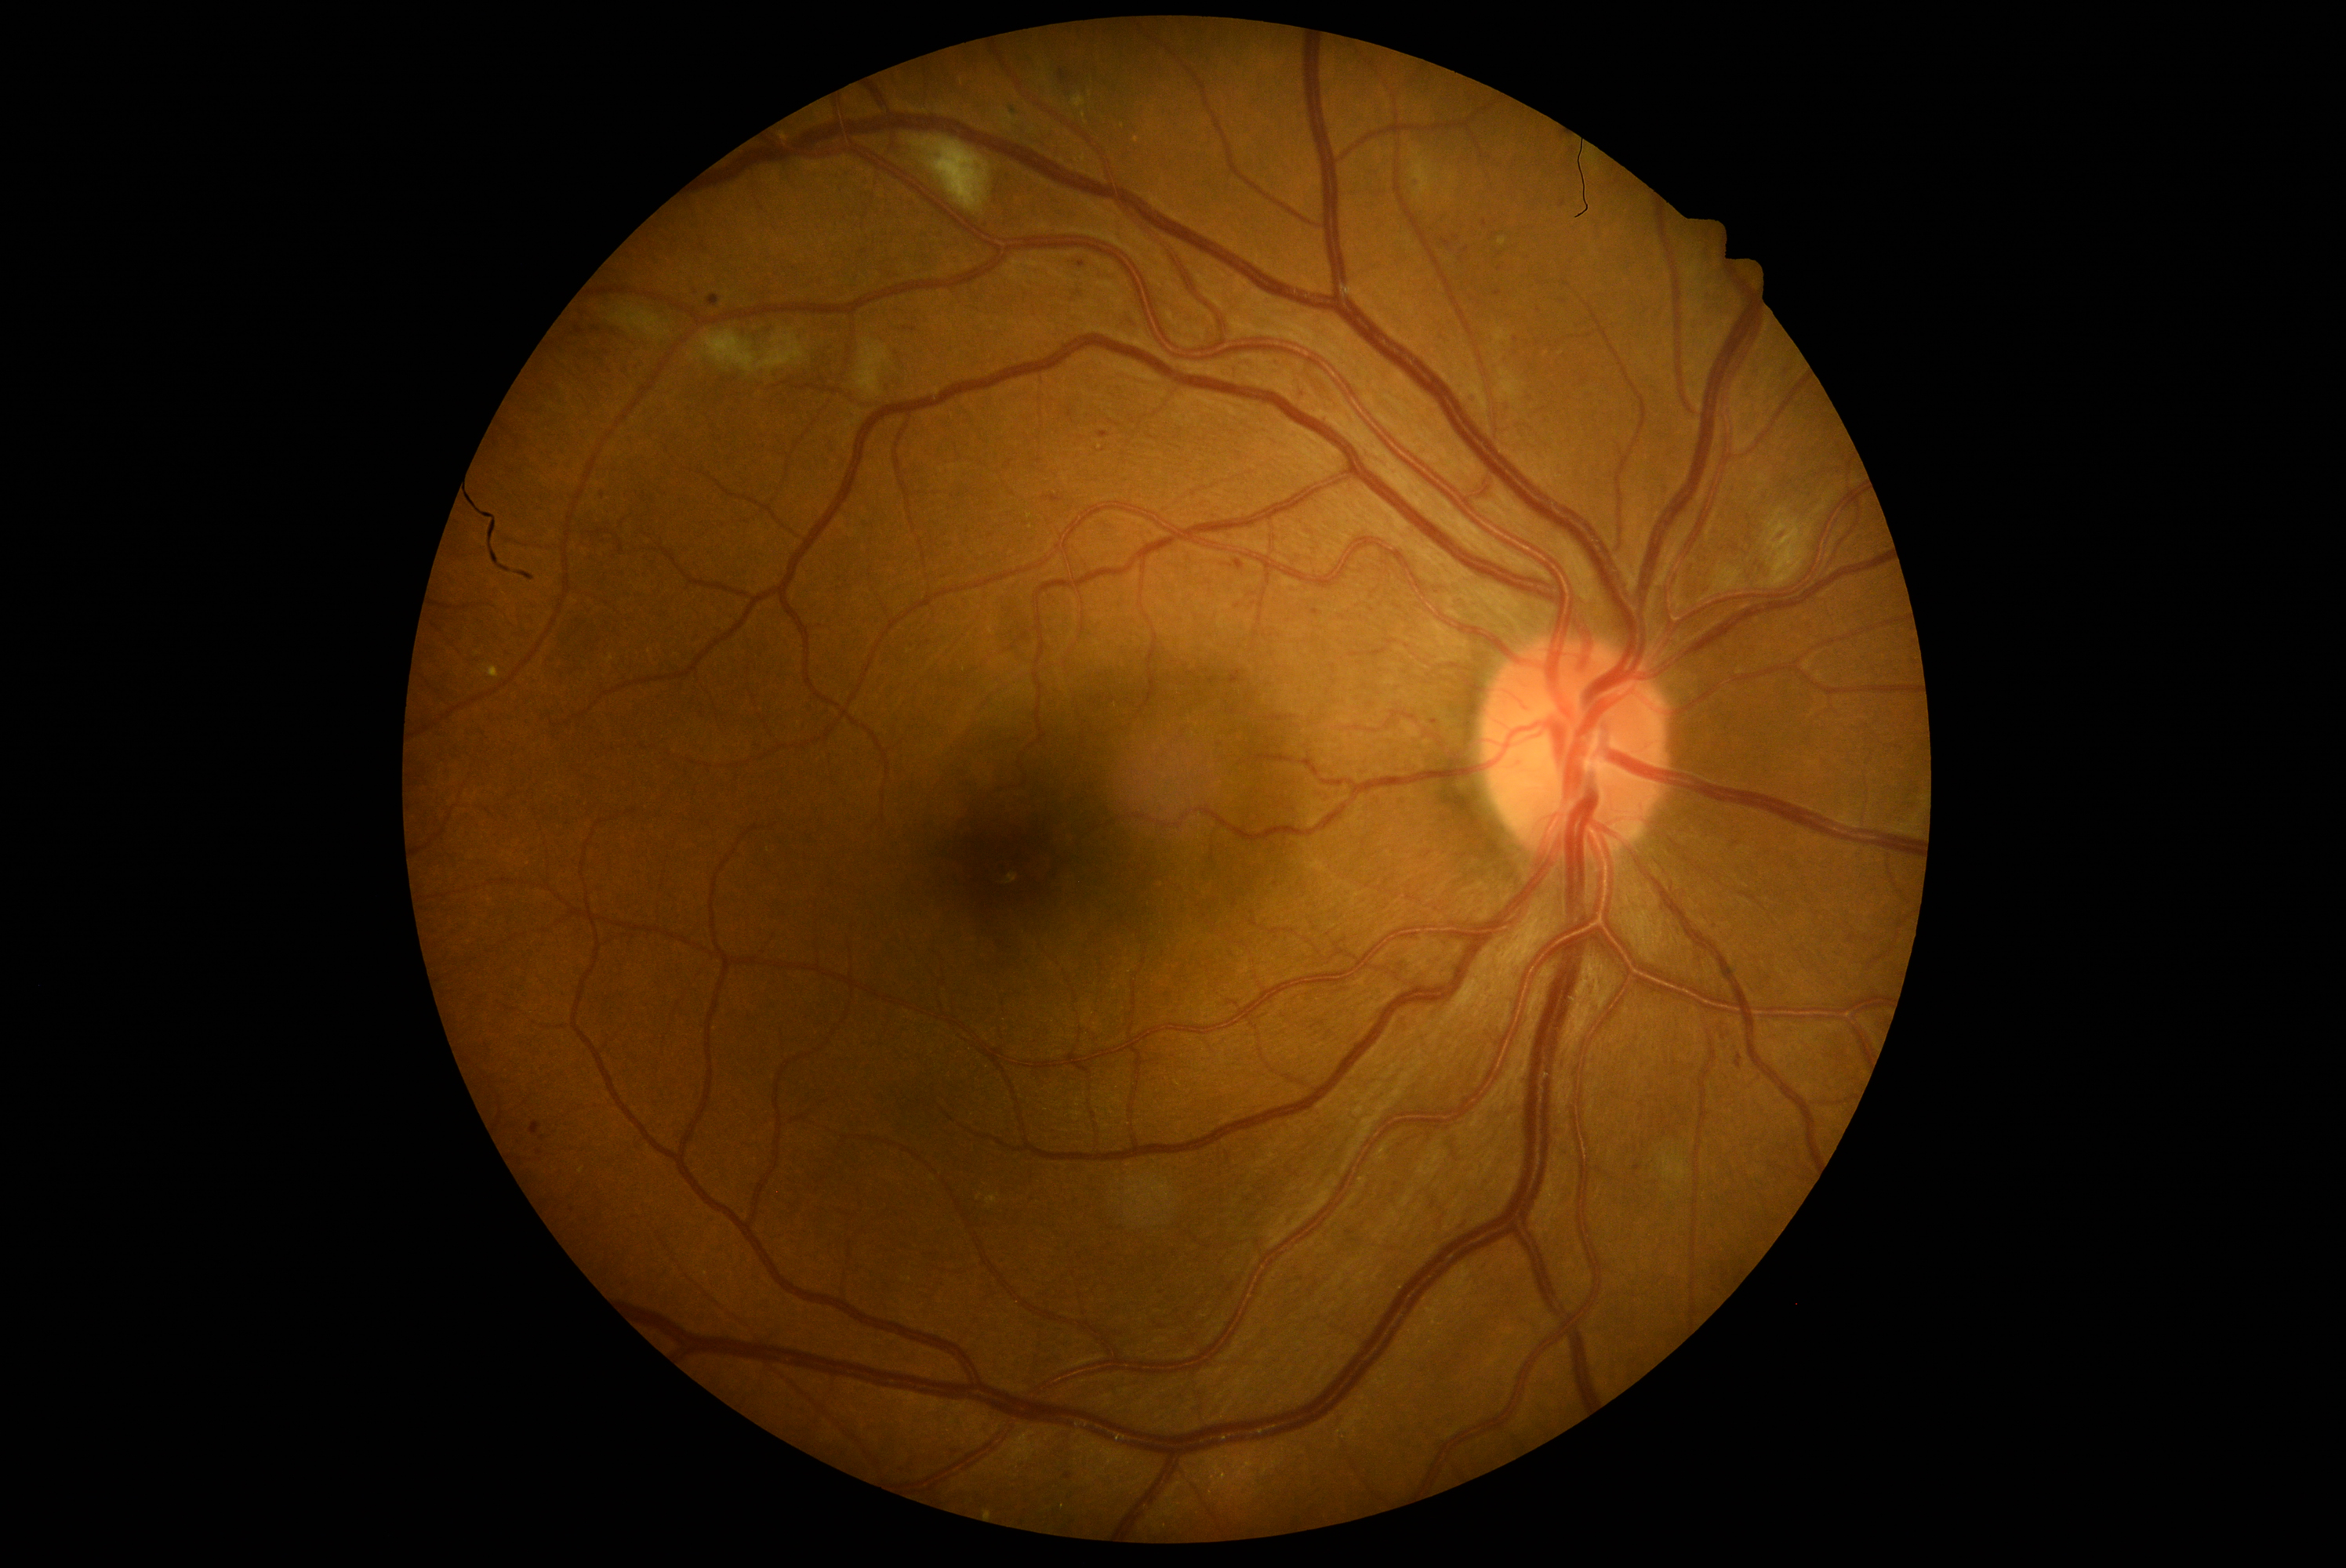 Disease class: non-proliferative diabetic retinopathy. Diabetic retinopathy: 2.